Captured with the Natus RetCam Envision (130° field of view). 1440 x 1080 pixels. Wide-field fundus image from infant ROP screening:
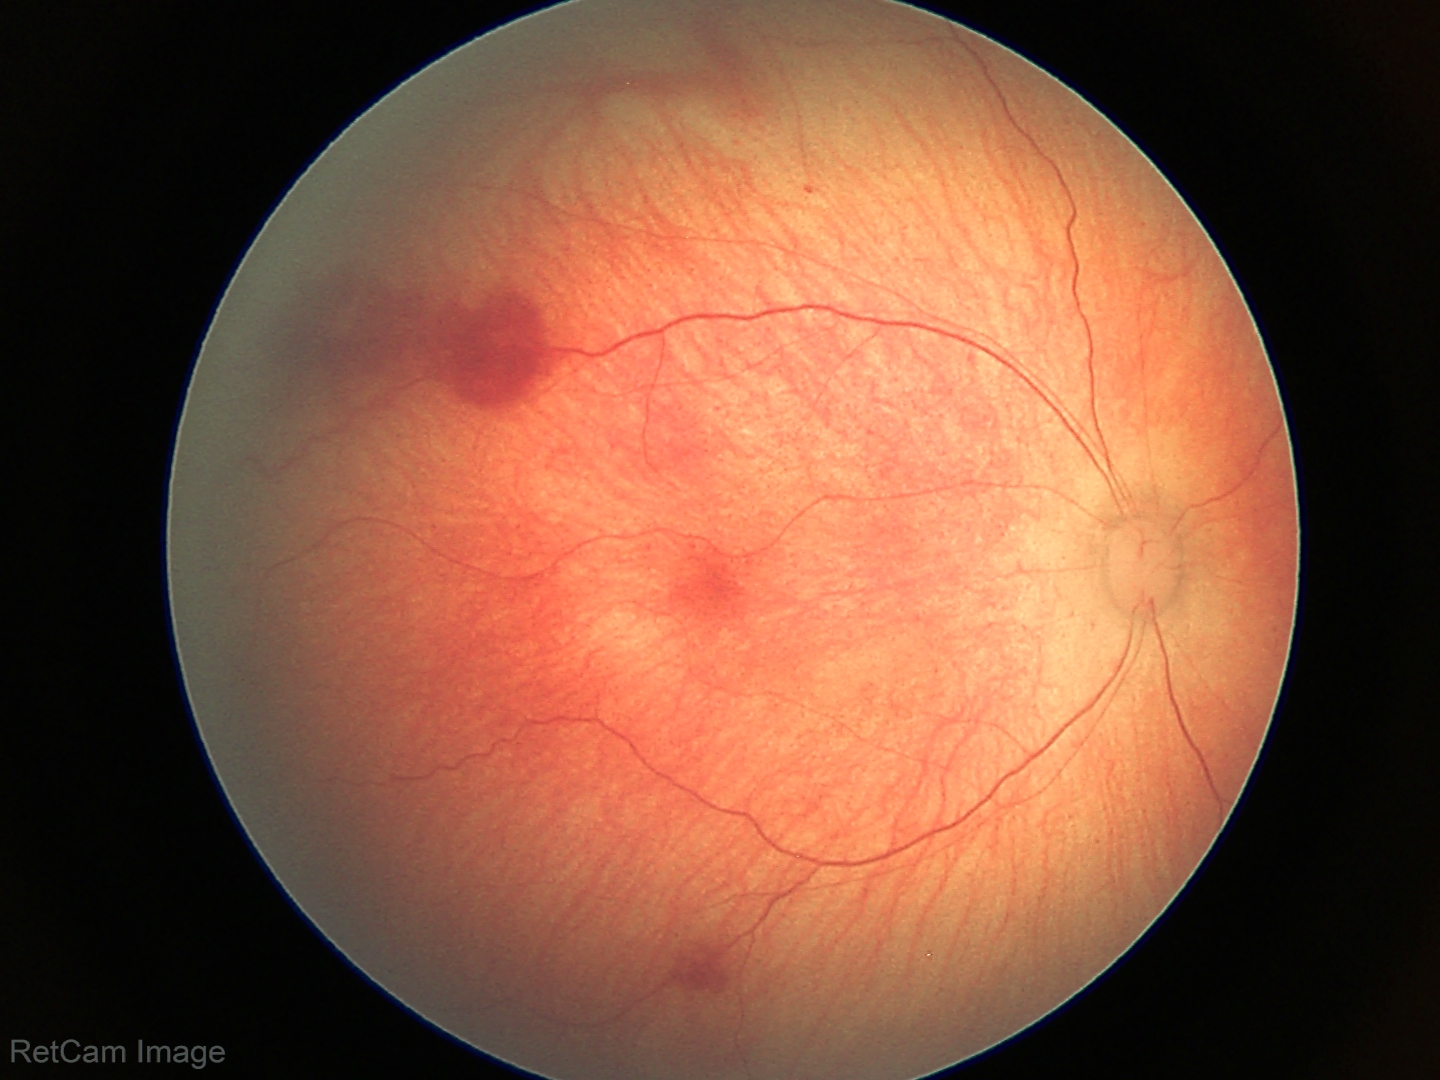 Series diagnosed as retinal hemorrhages.